45° FOV, 1932 by 1916 pixels: 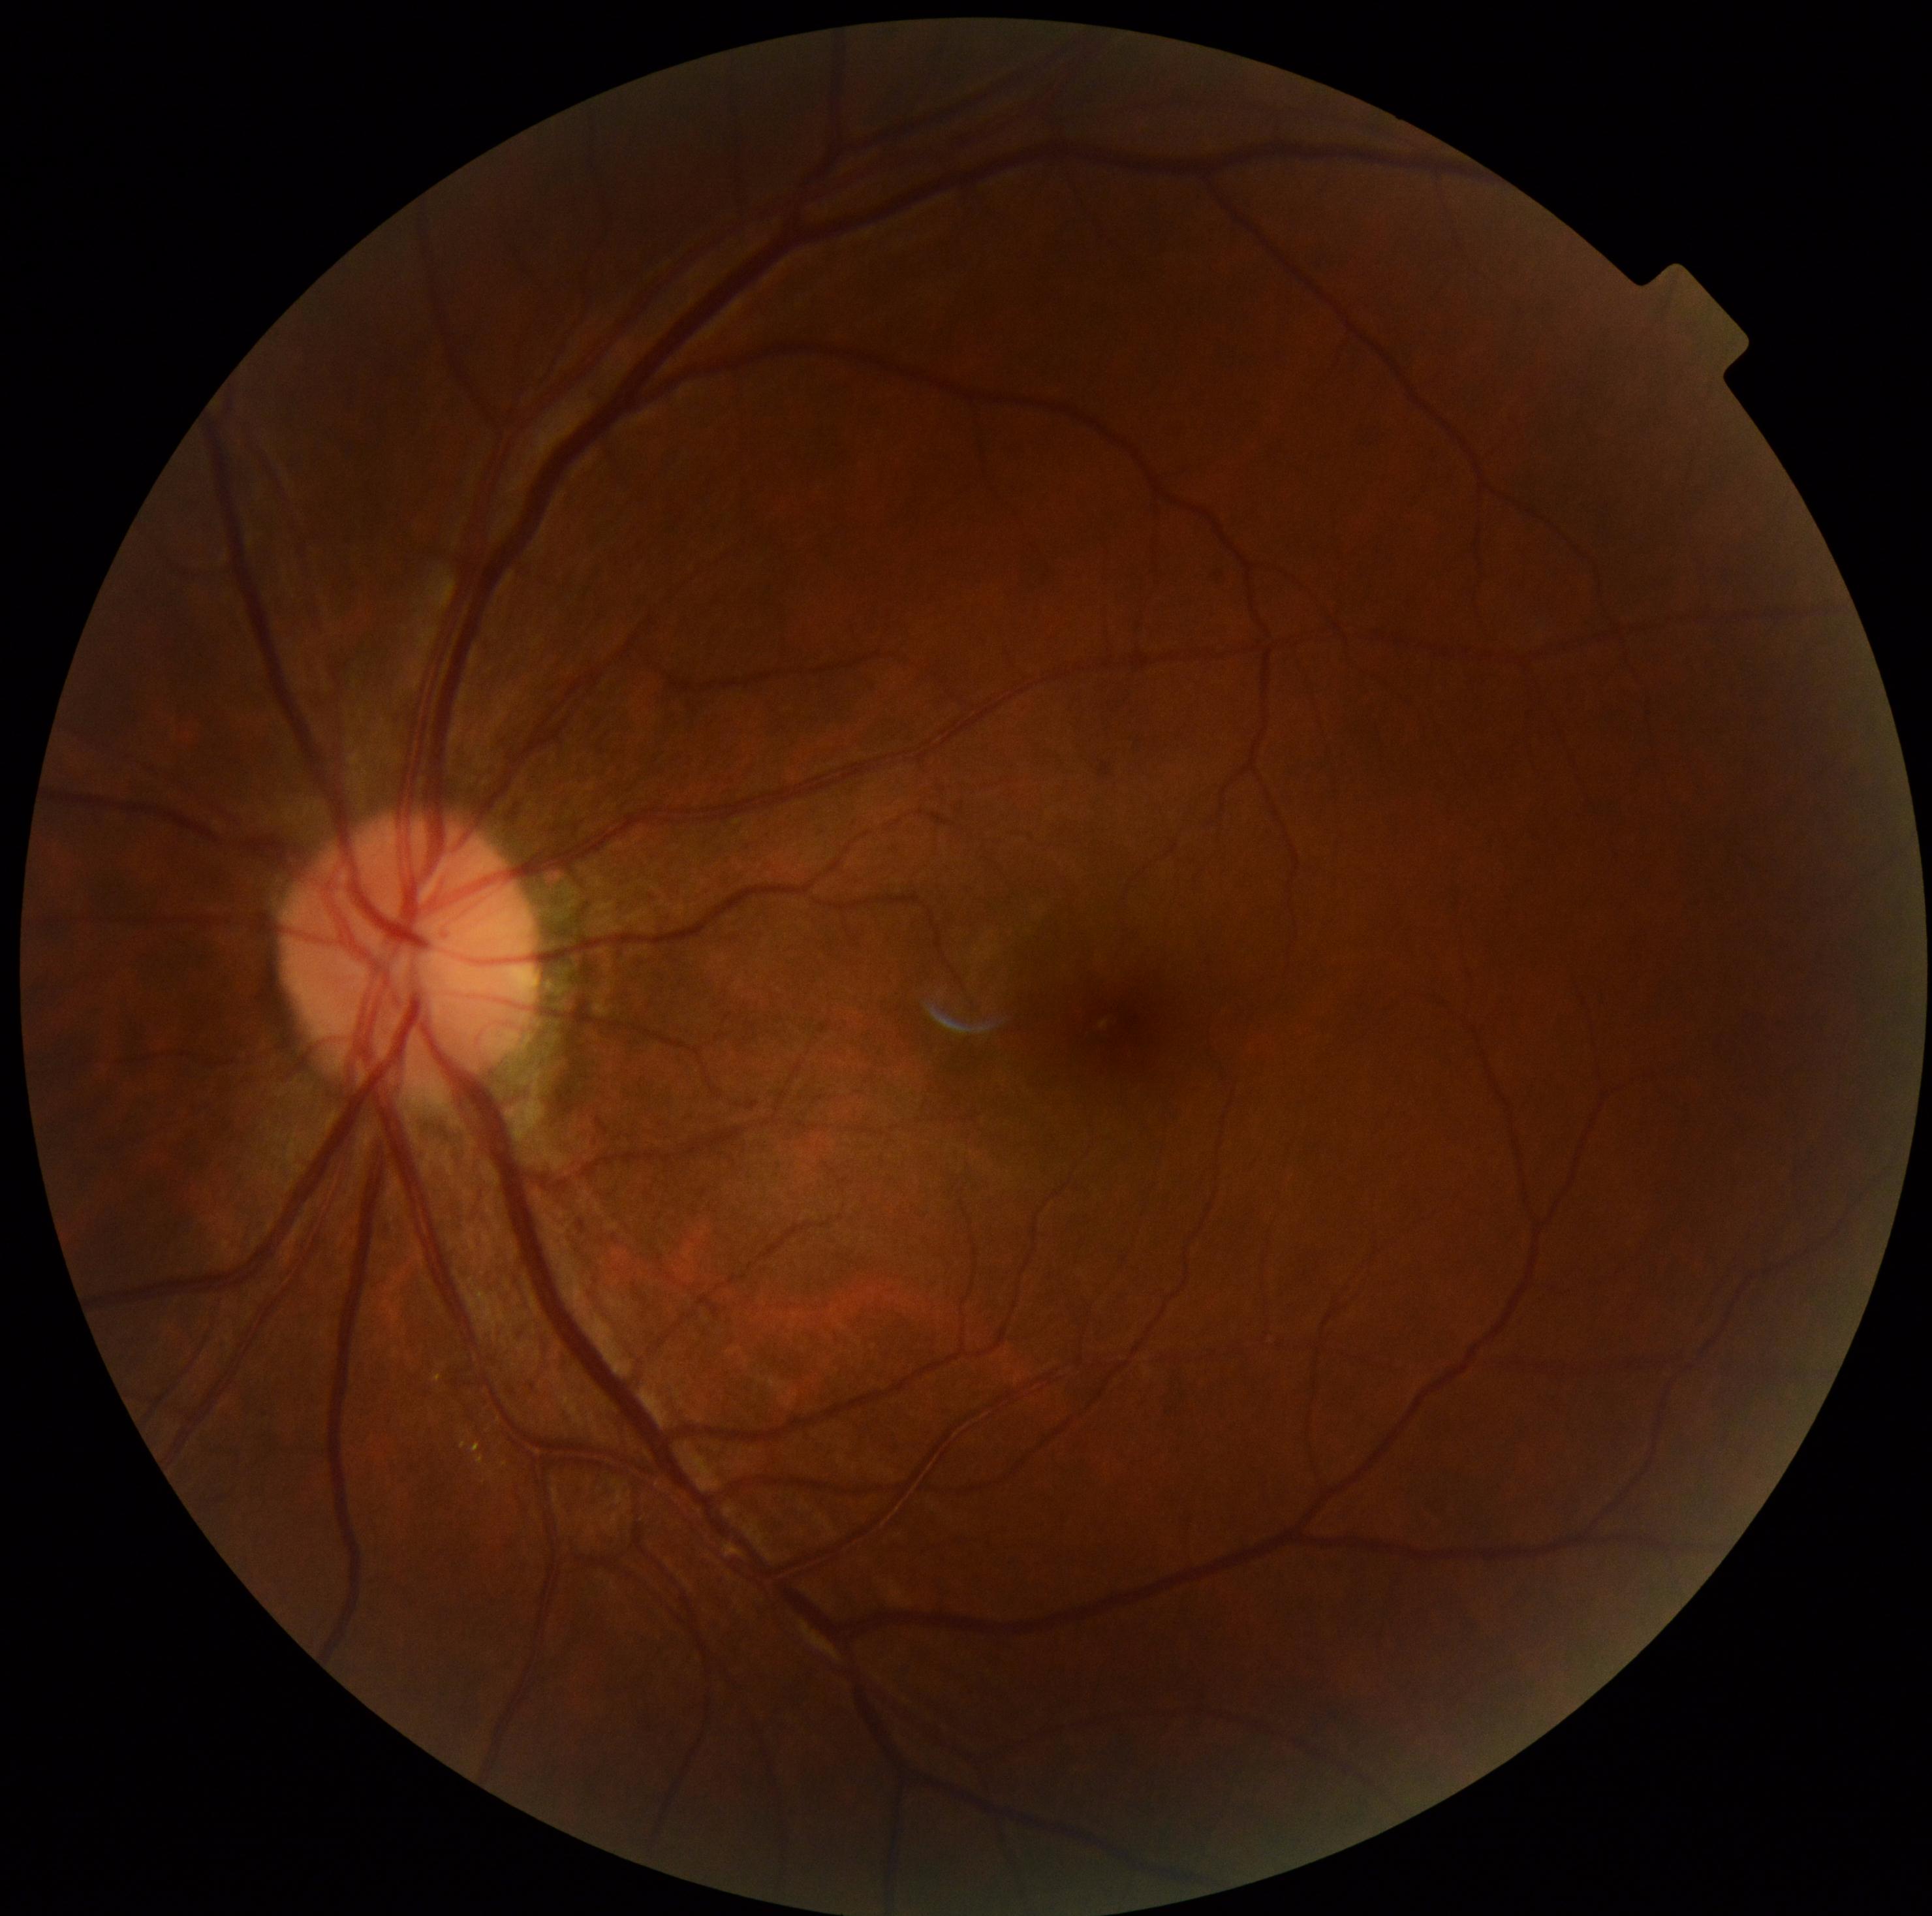

DR severity is 0.